1932x1932px. CFP: 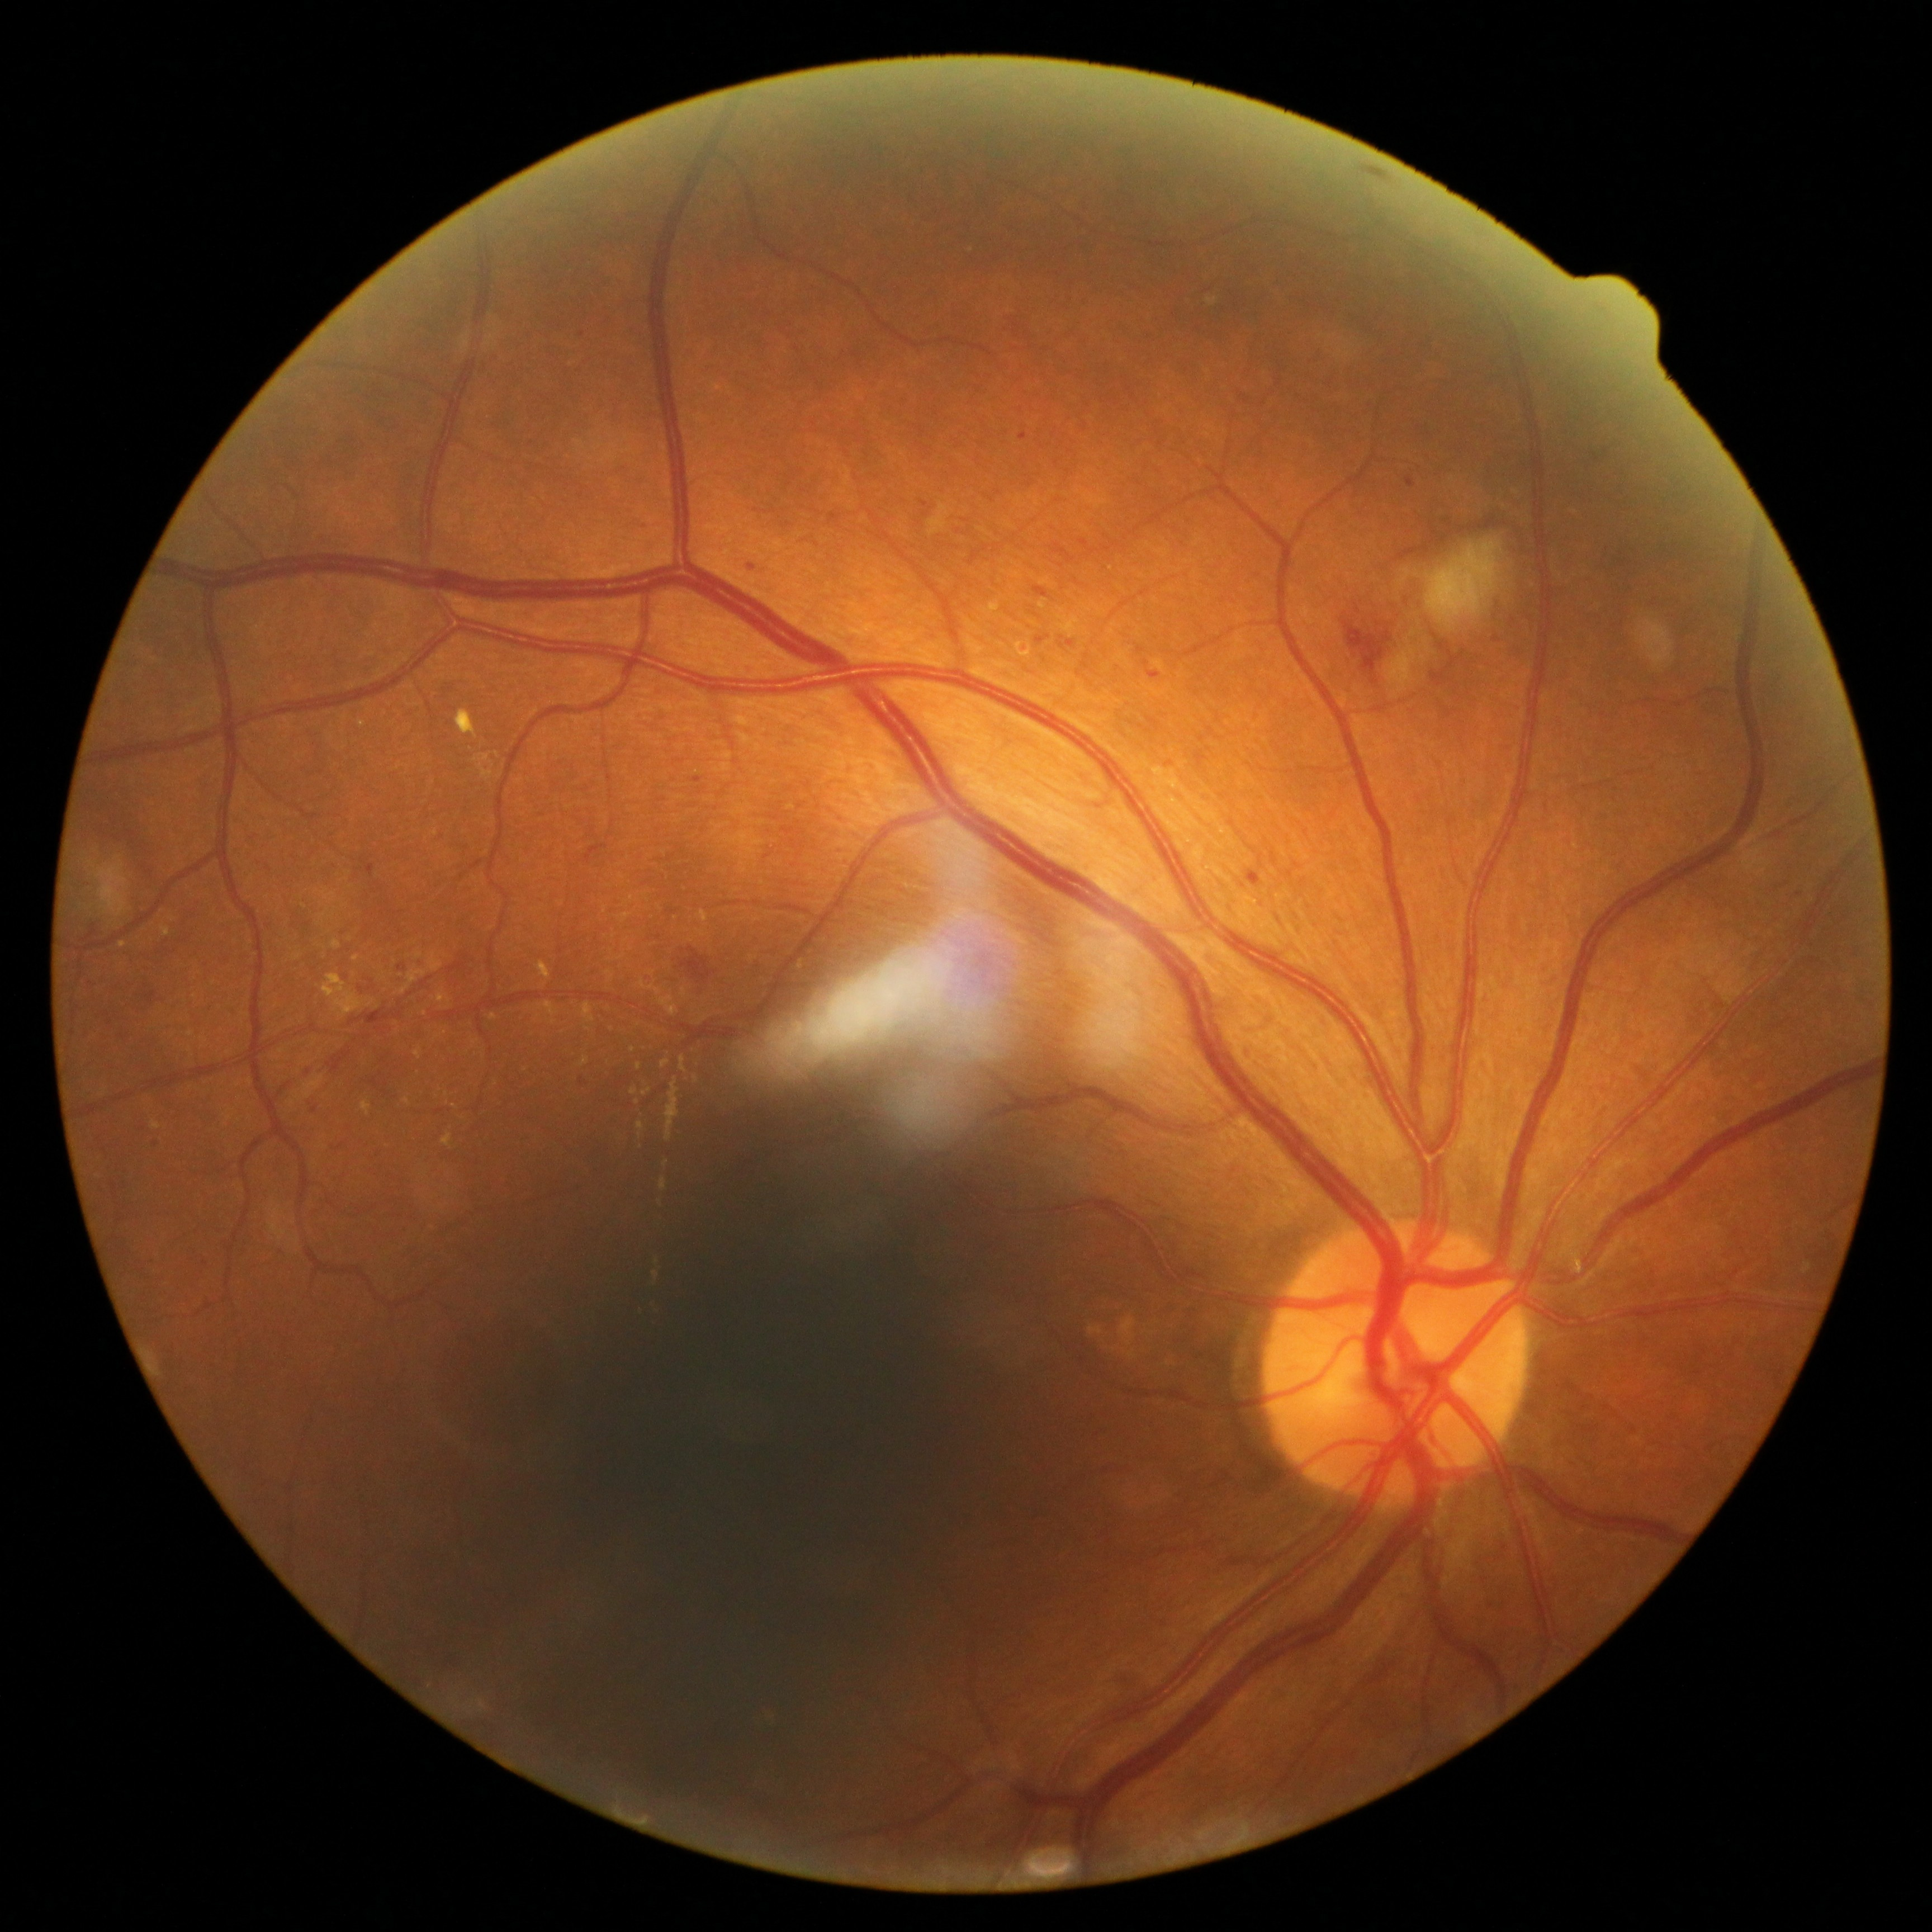

dr_grade: grade 2